848x848. Davis DR grading. 45° FOV.
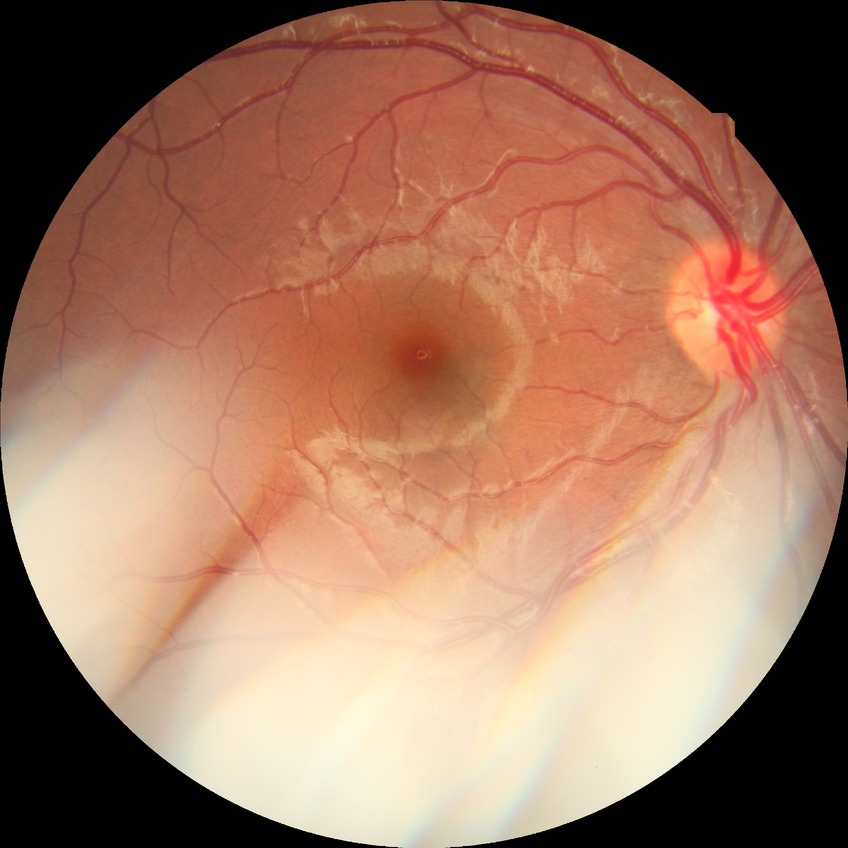

Assessment:
- retinopathy grade: no diabetic retinopathy